Optic disc-centered crop from a color fundus photograph. Cropped from a 35-degree field of view
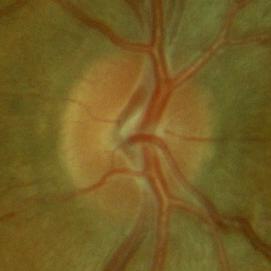

Findings consistent with no signs of glaucoma.